Image size 2352x1568 — 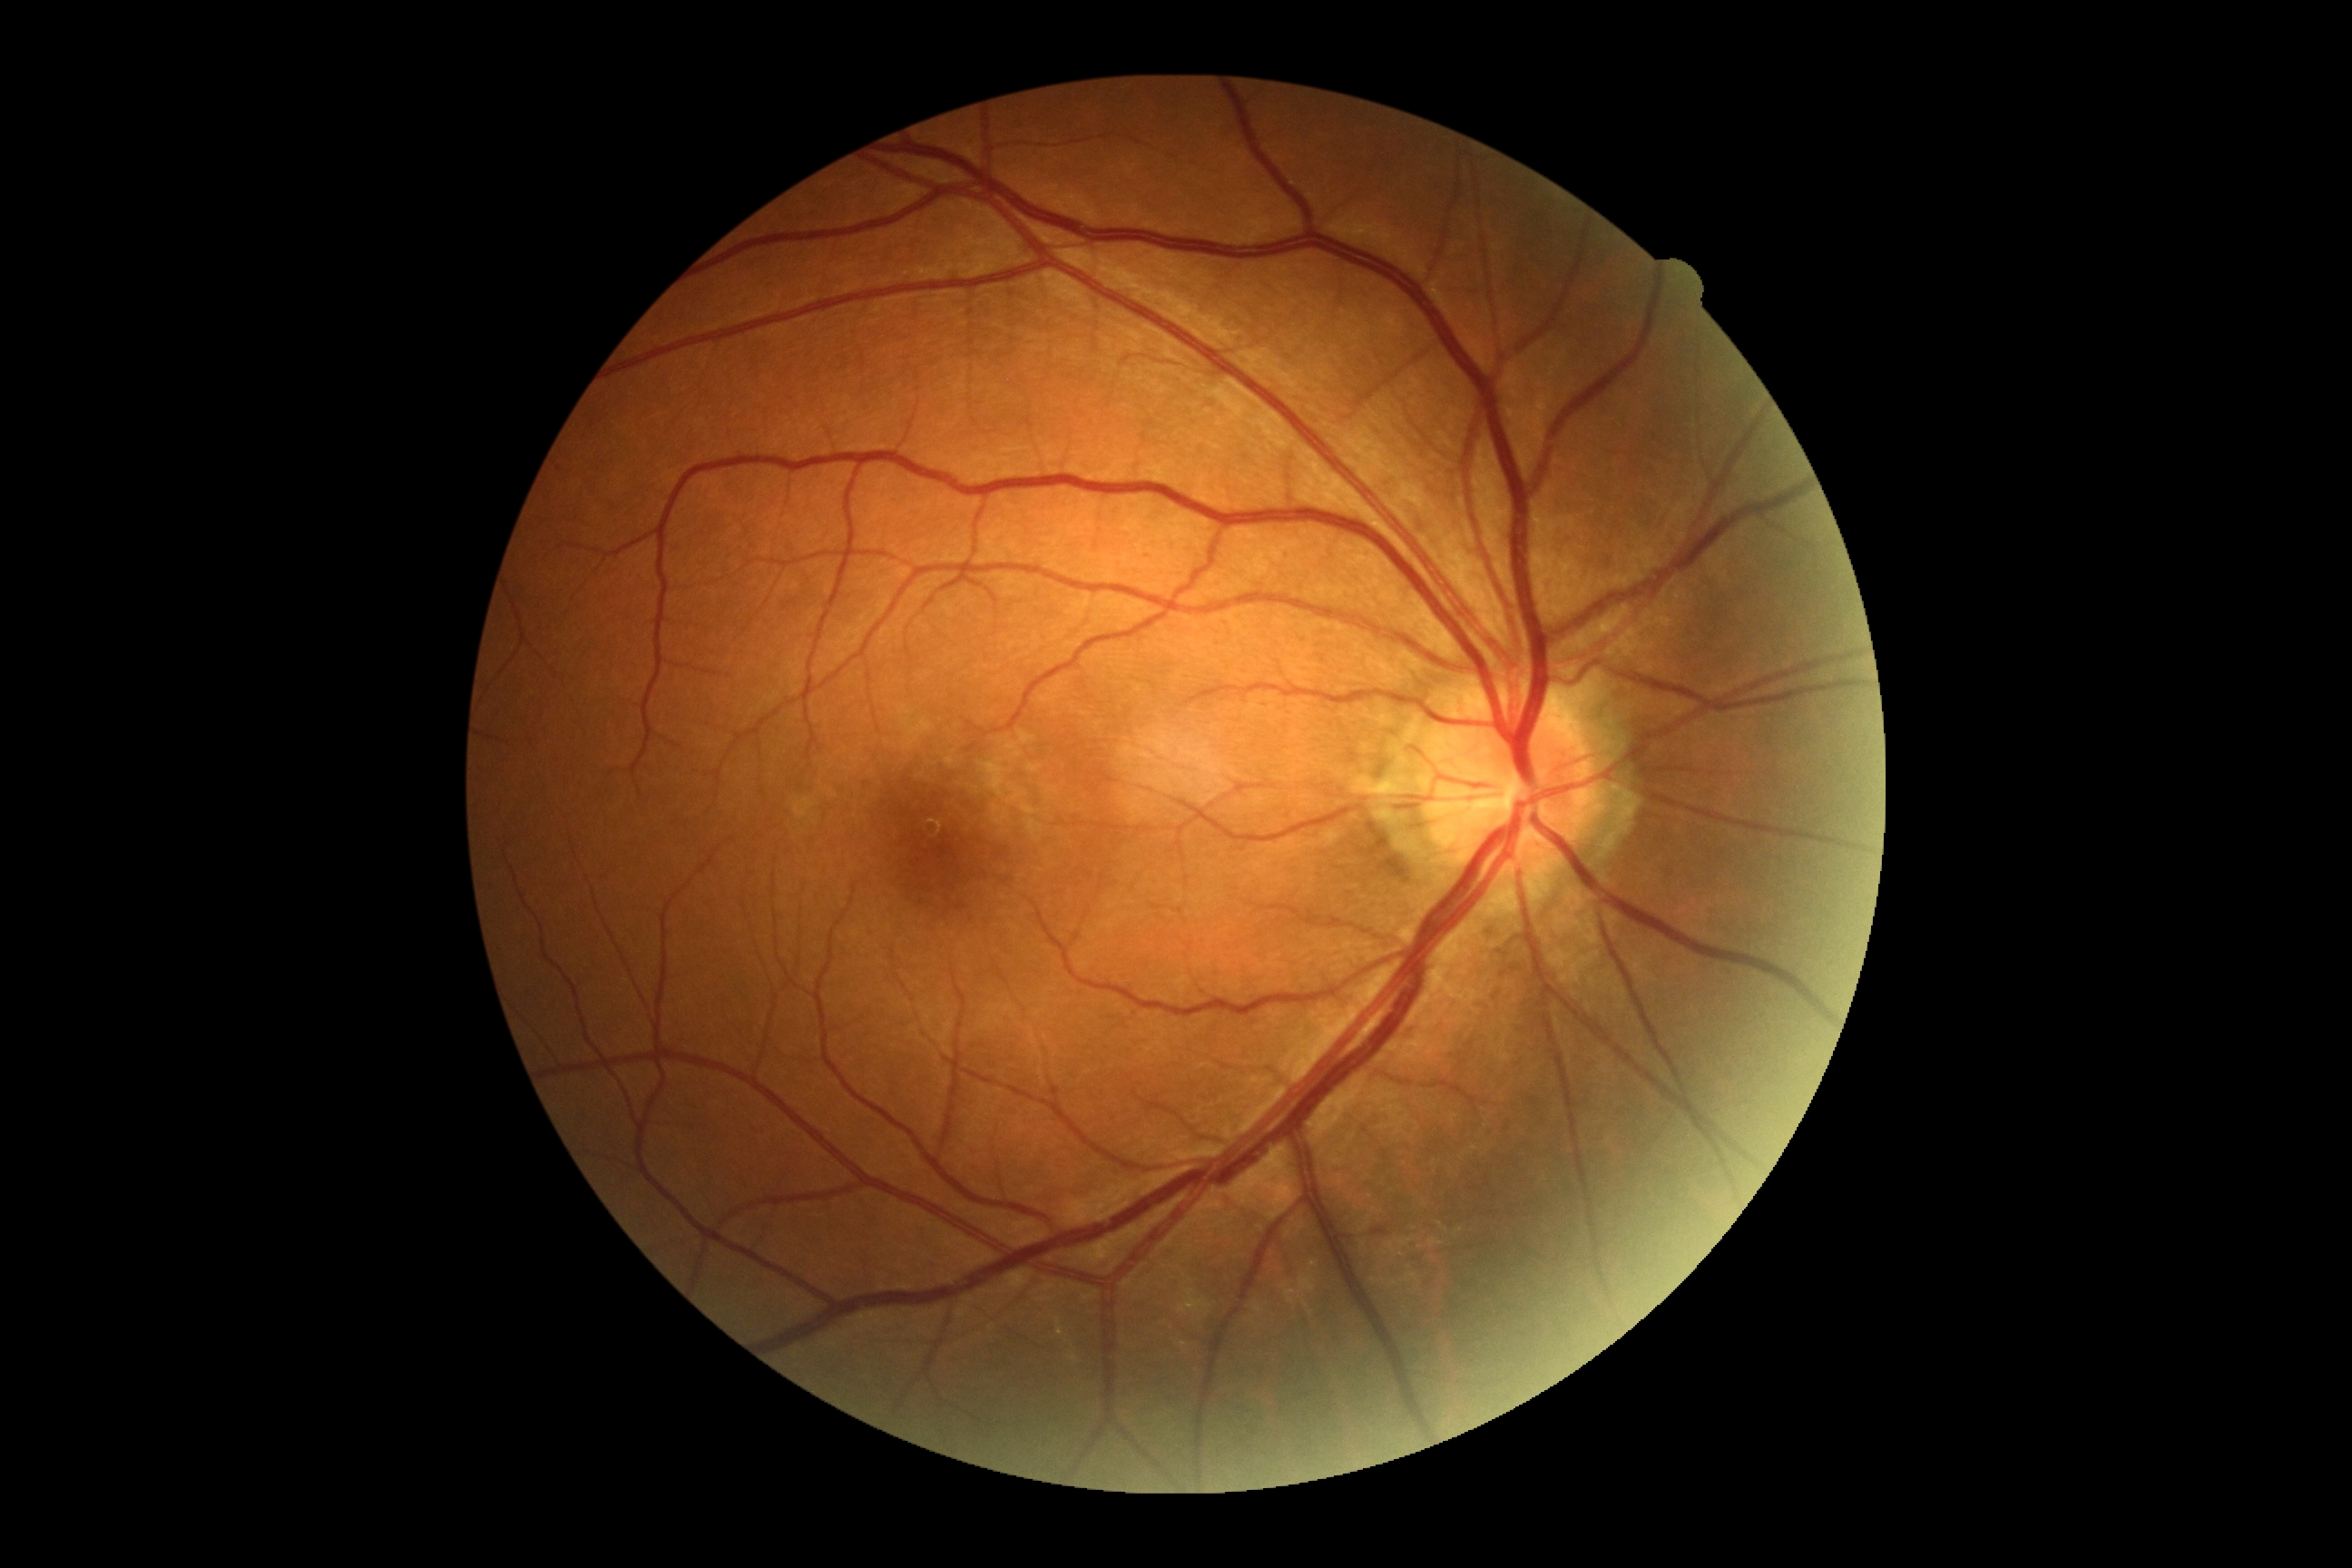
Retinopathy grade: no apparent diabetic retinopathy (0).
No apparent diabetic retinopathy.